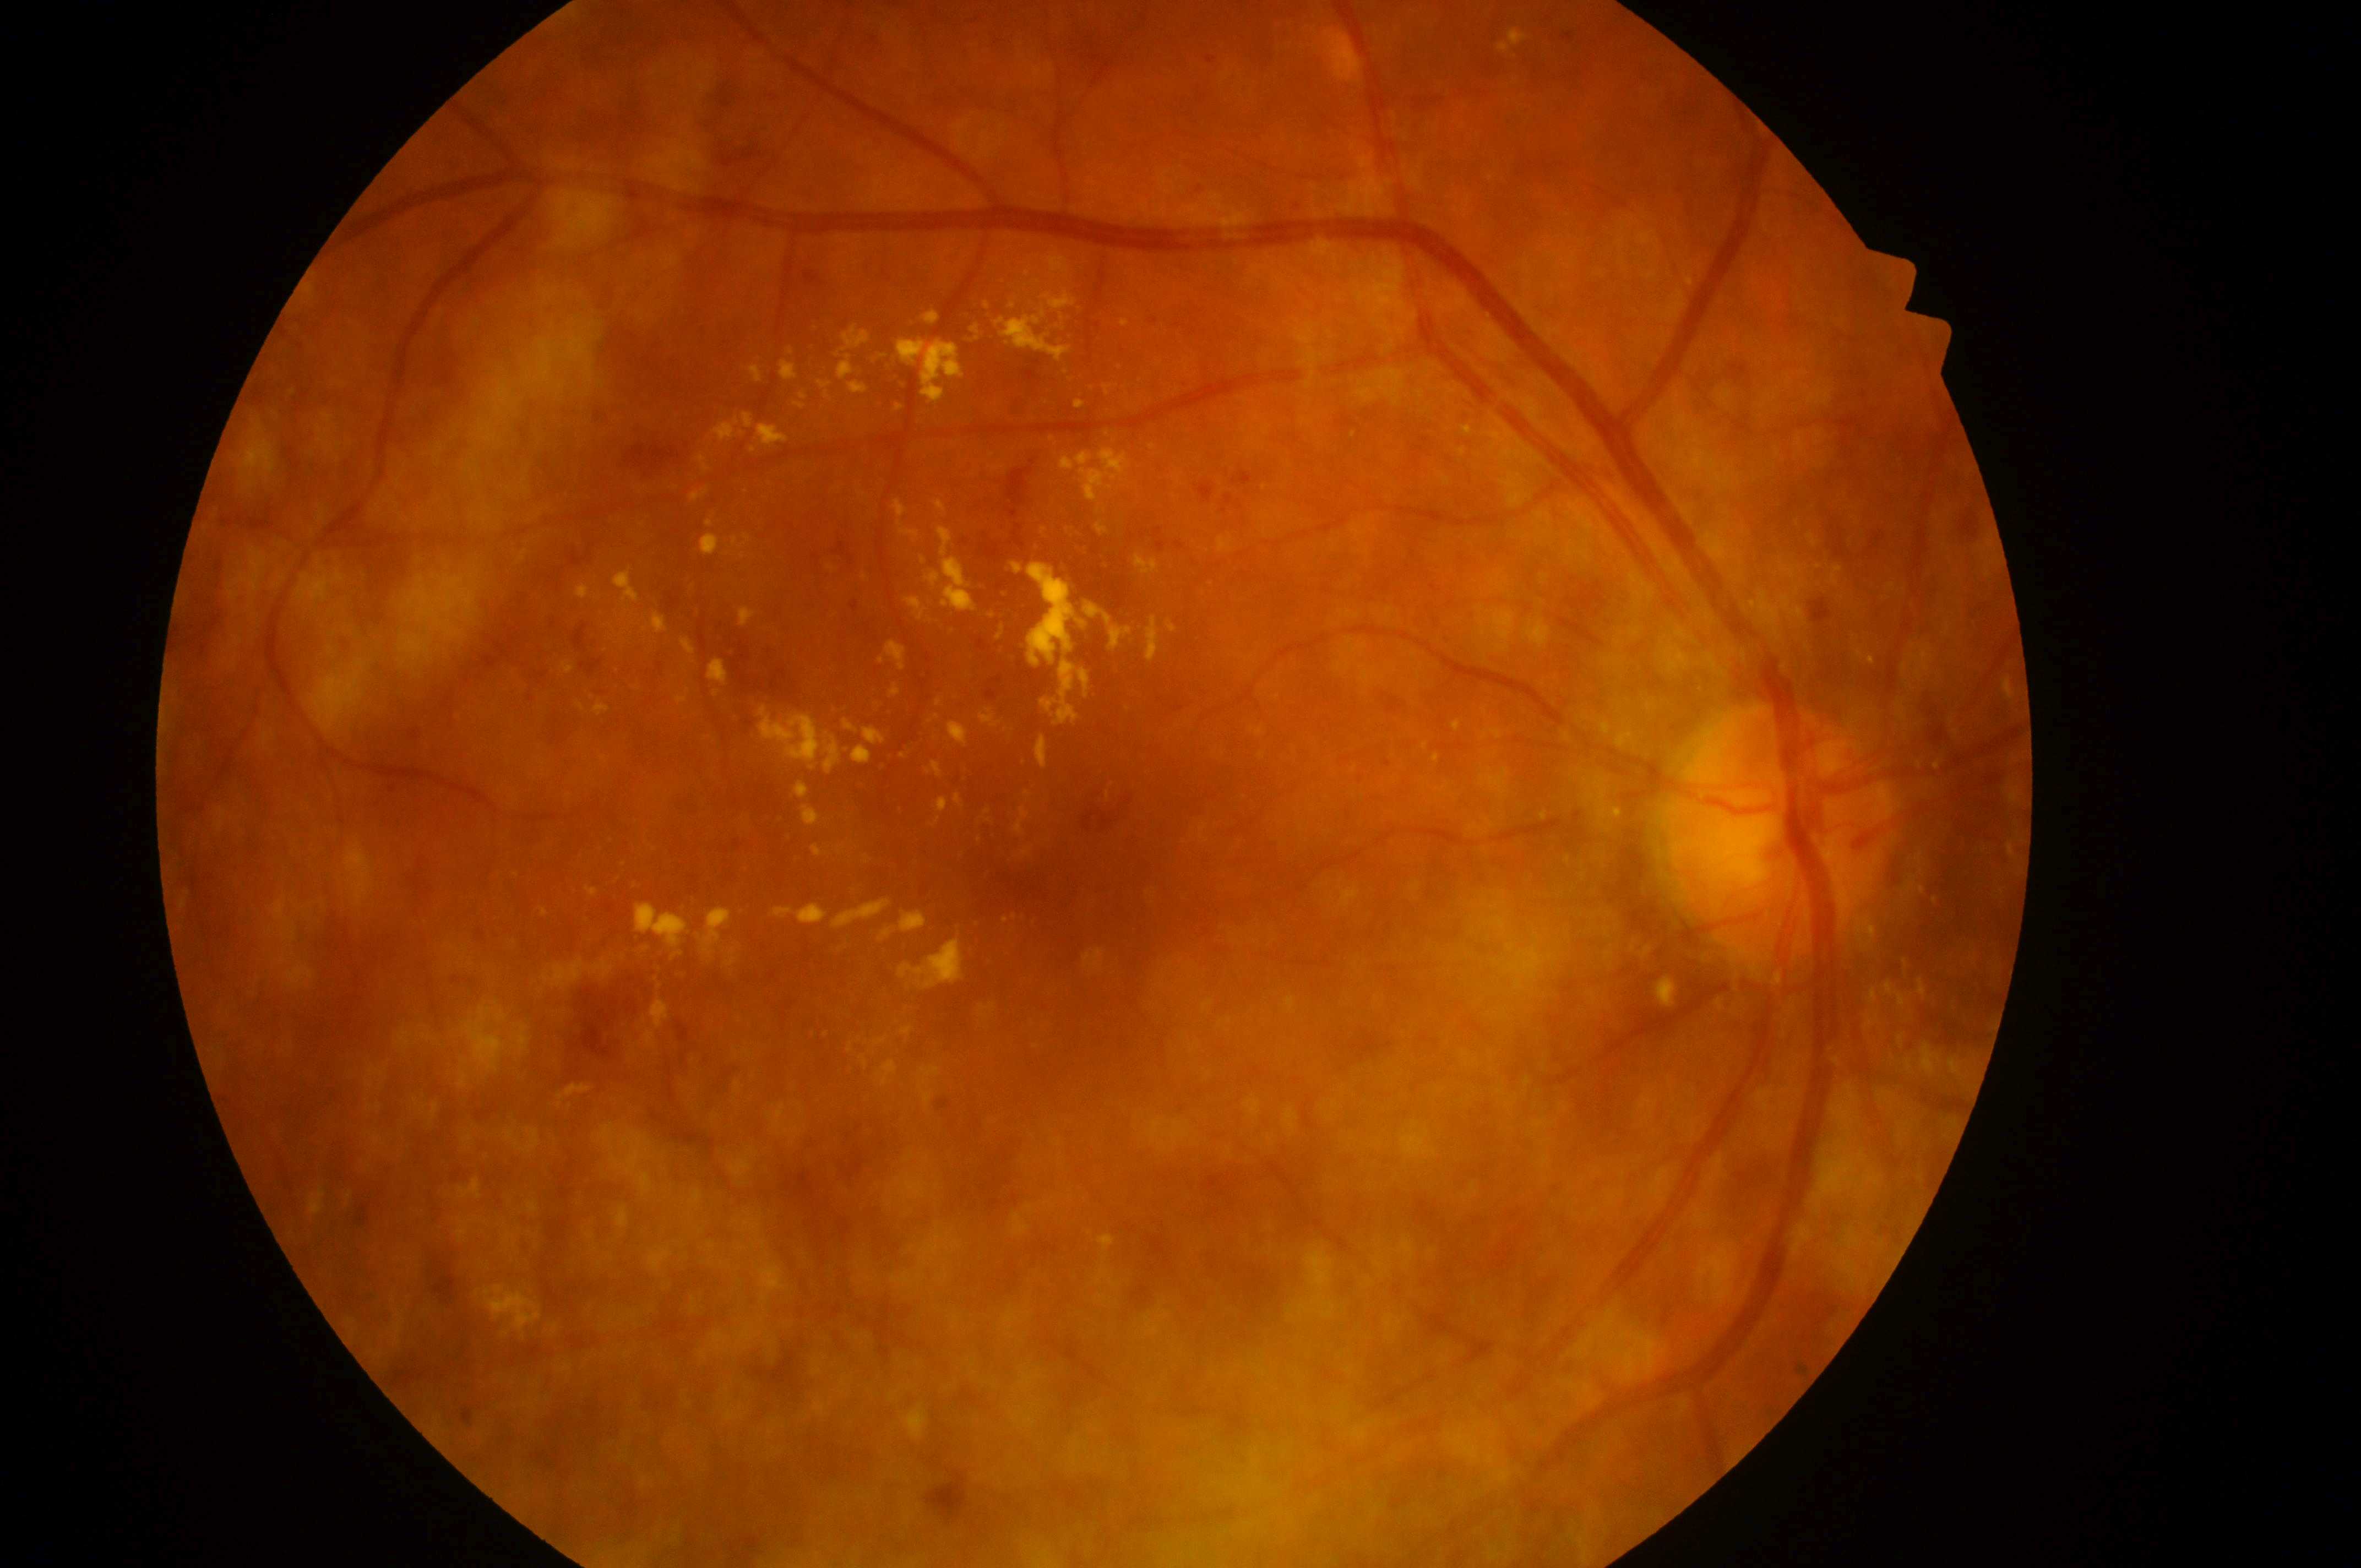
Diabetic retinopathy (DR) is grade 3 (severe NPDR) — more than 20 intraretinal hemorrhages in each of 4 quadrants, definite venous beading in 2 or more quadrants, or prominent intraretinal microvascular abnormalities in 1 or more quadrants, with no signs of proliferative retinopathy.
Eye: OD.
Macular center located at (1095,874).
Diabetic macular edema (DME) is high risk (grade 2) — hard exudates within one disc diameter of the macula center.
Optic disc: (1774,845).